Pediatric retinal photograph (wide-field):
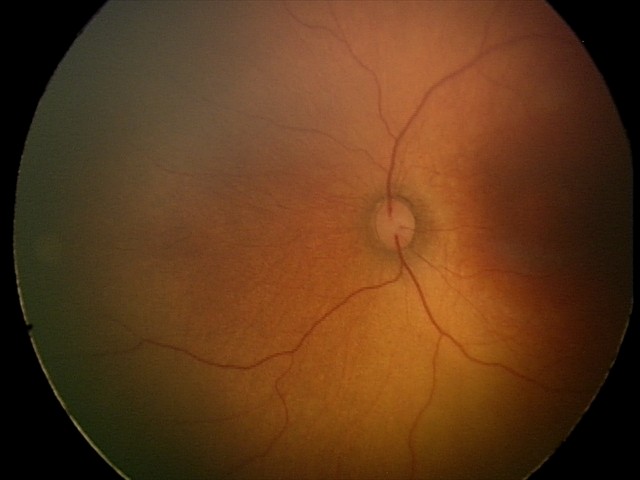
Physiological retinal appearance for postconceptual age.